240x240px
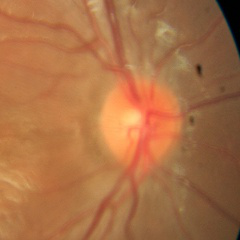 Optic disc appearance consistent with no glaucomatous findings.